Color fundus image:
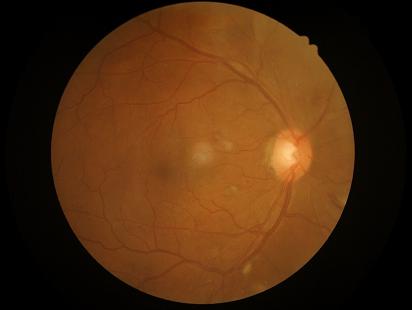

Acceptable image quality.
Image is sharp throughout the field.